FOV: 45 degrees · CFP: 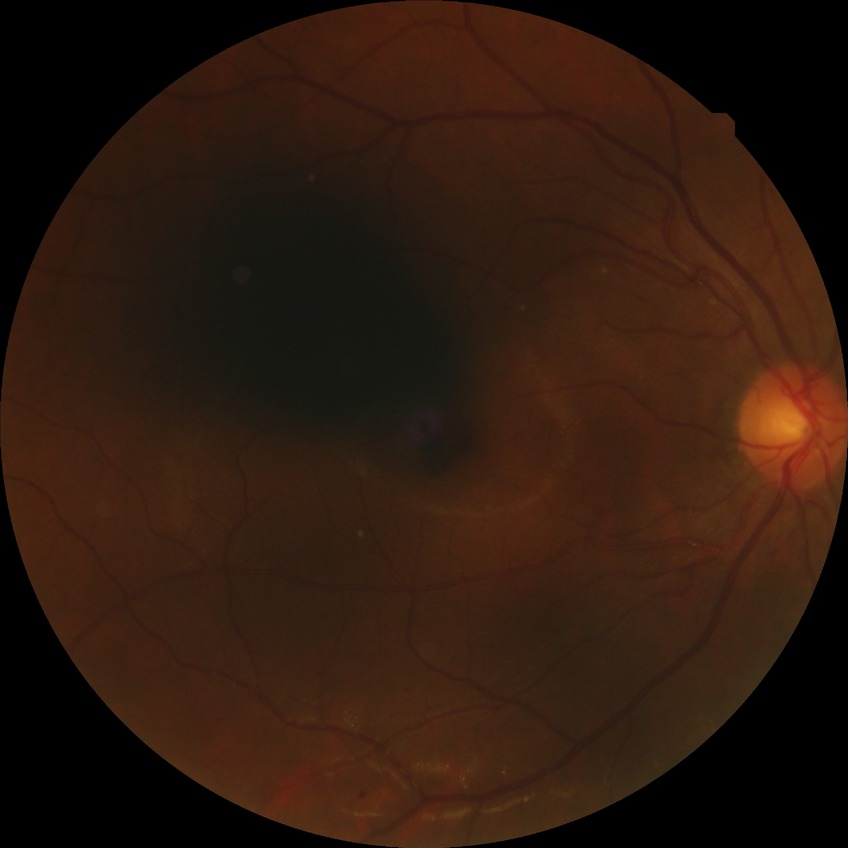

DR stage is SDR. Disease class: non-proliferative diabetic retinopathy.